Without pupil dilation · graded on the modified Davis scale · acquired with a NIDEK AFC-230 · fundus photo · image size 848x848: 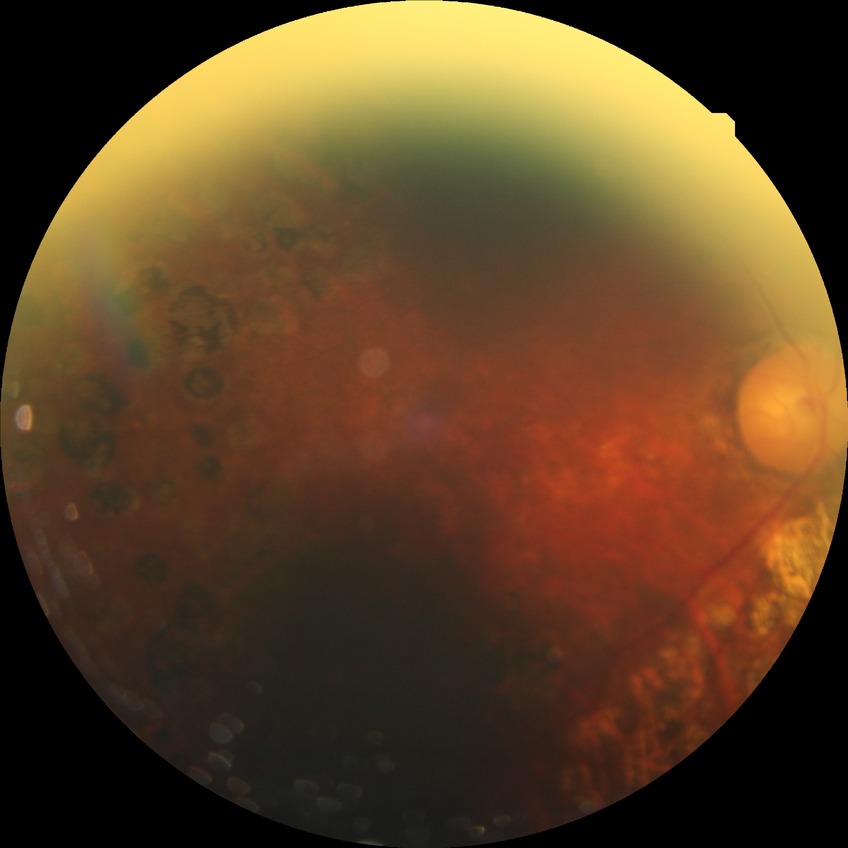
Diabetic retinopathy (DR): PDR (proliferative diabetic retinopathy).